Wide-field fundus image from infant ROP screening; camera: Phoenix ICON (100° FOV)
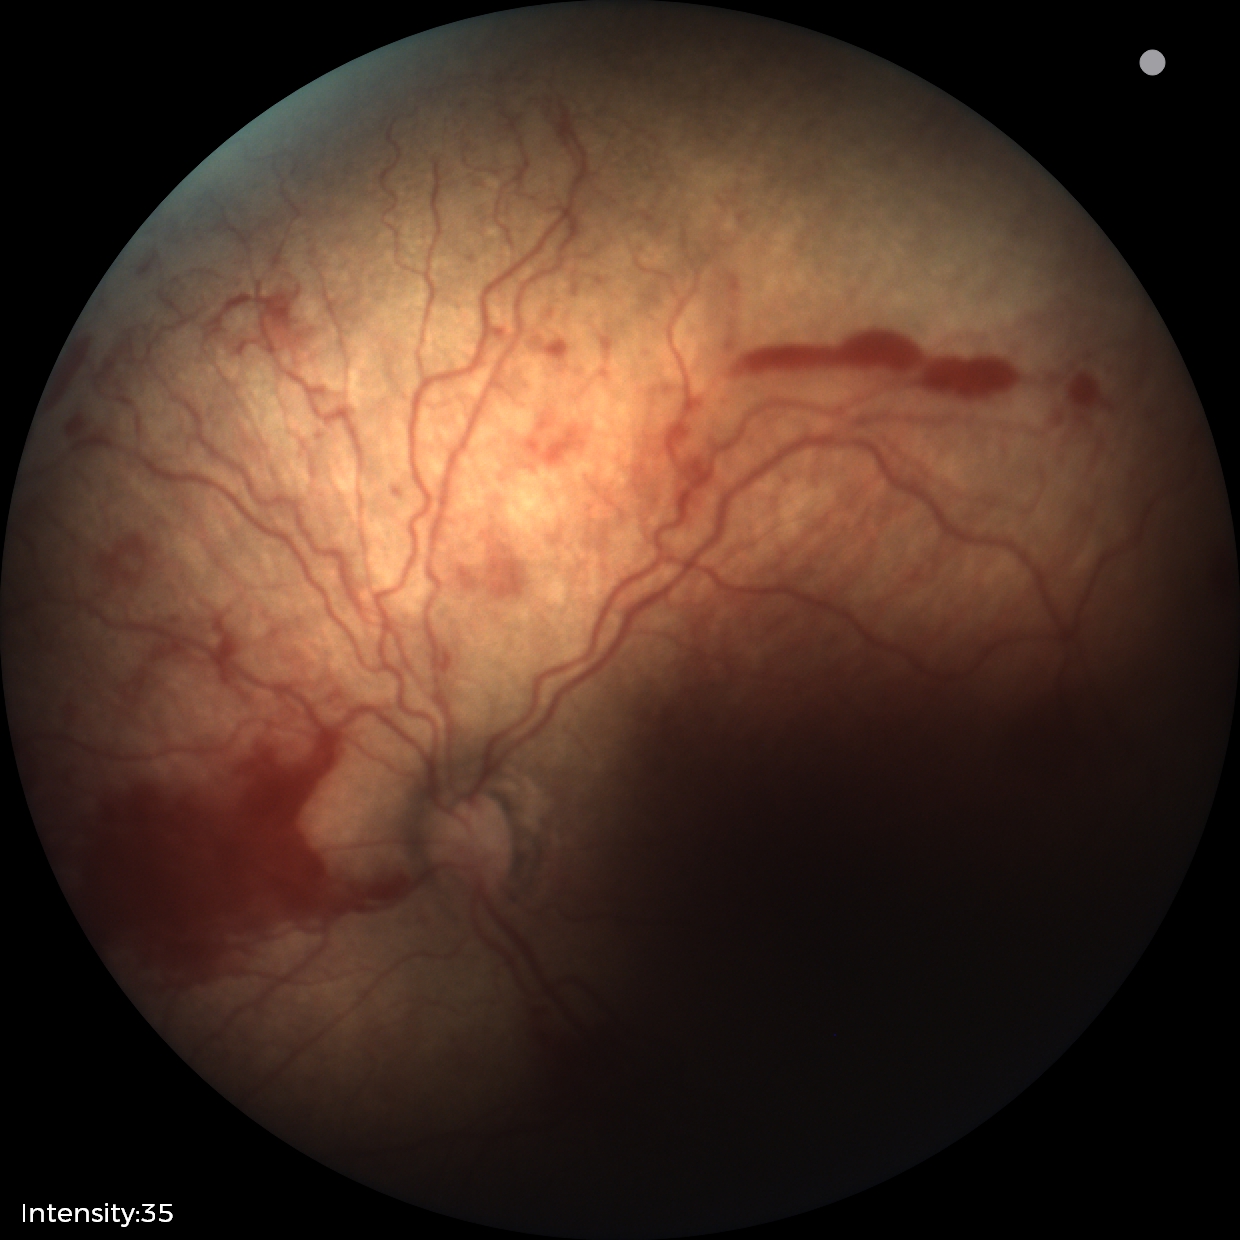

Plus form = present — abnormal dilation and tortuosity of the posterior pole retinal vessels, retinopathy of prematurity = stage 2.